45° FOV, 2212 x 1672 pixels, color fundus photograph: 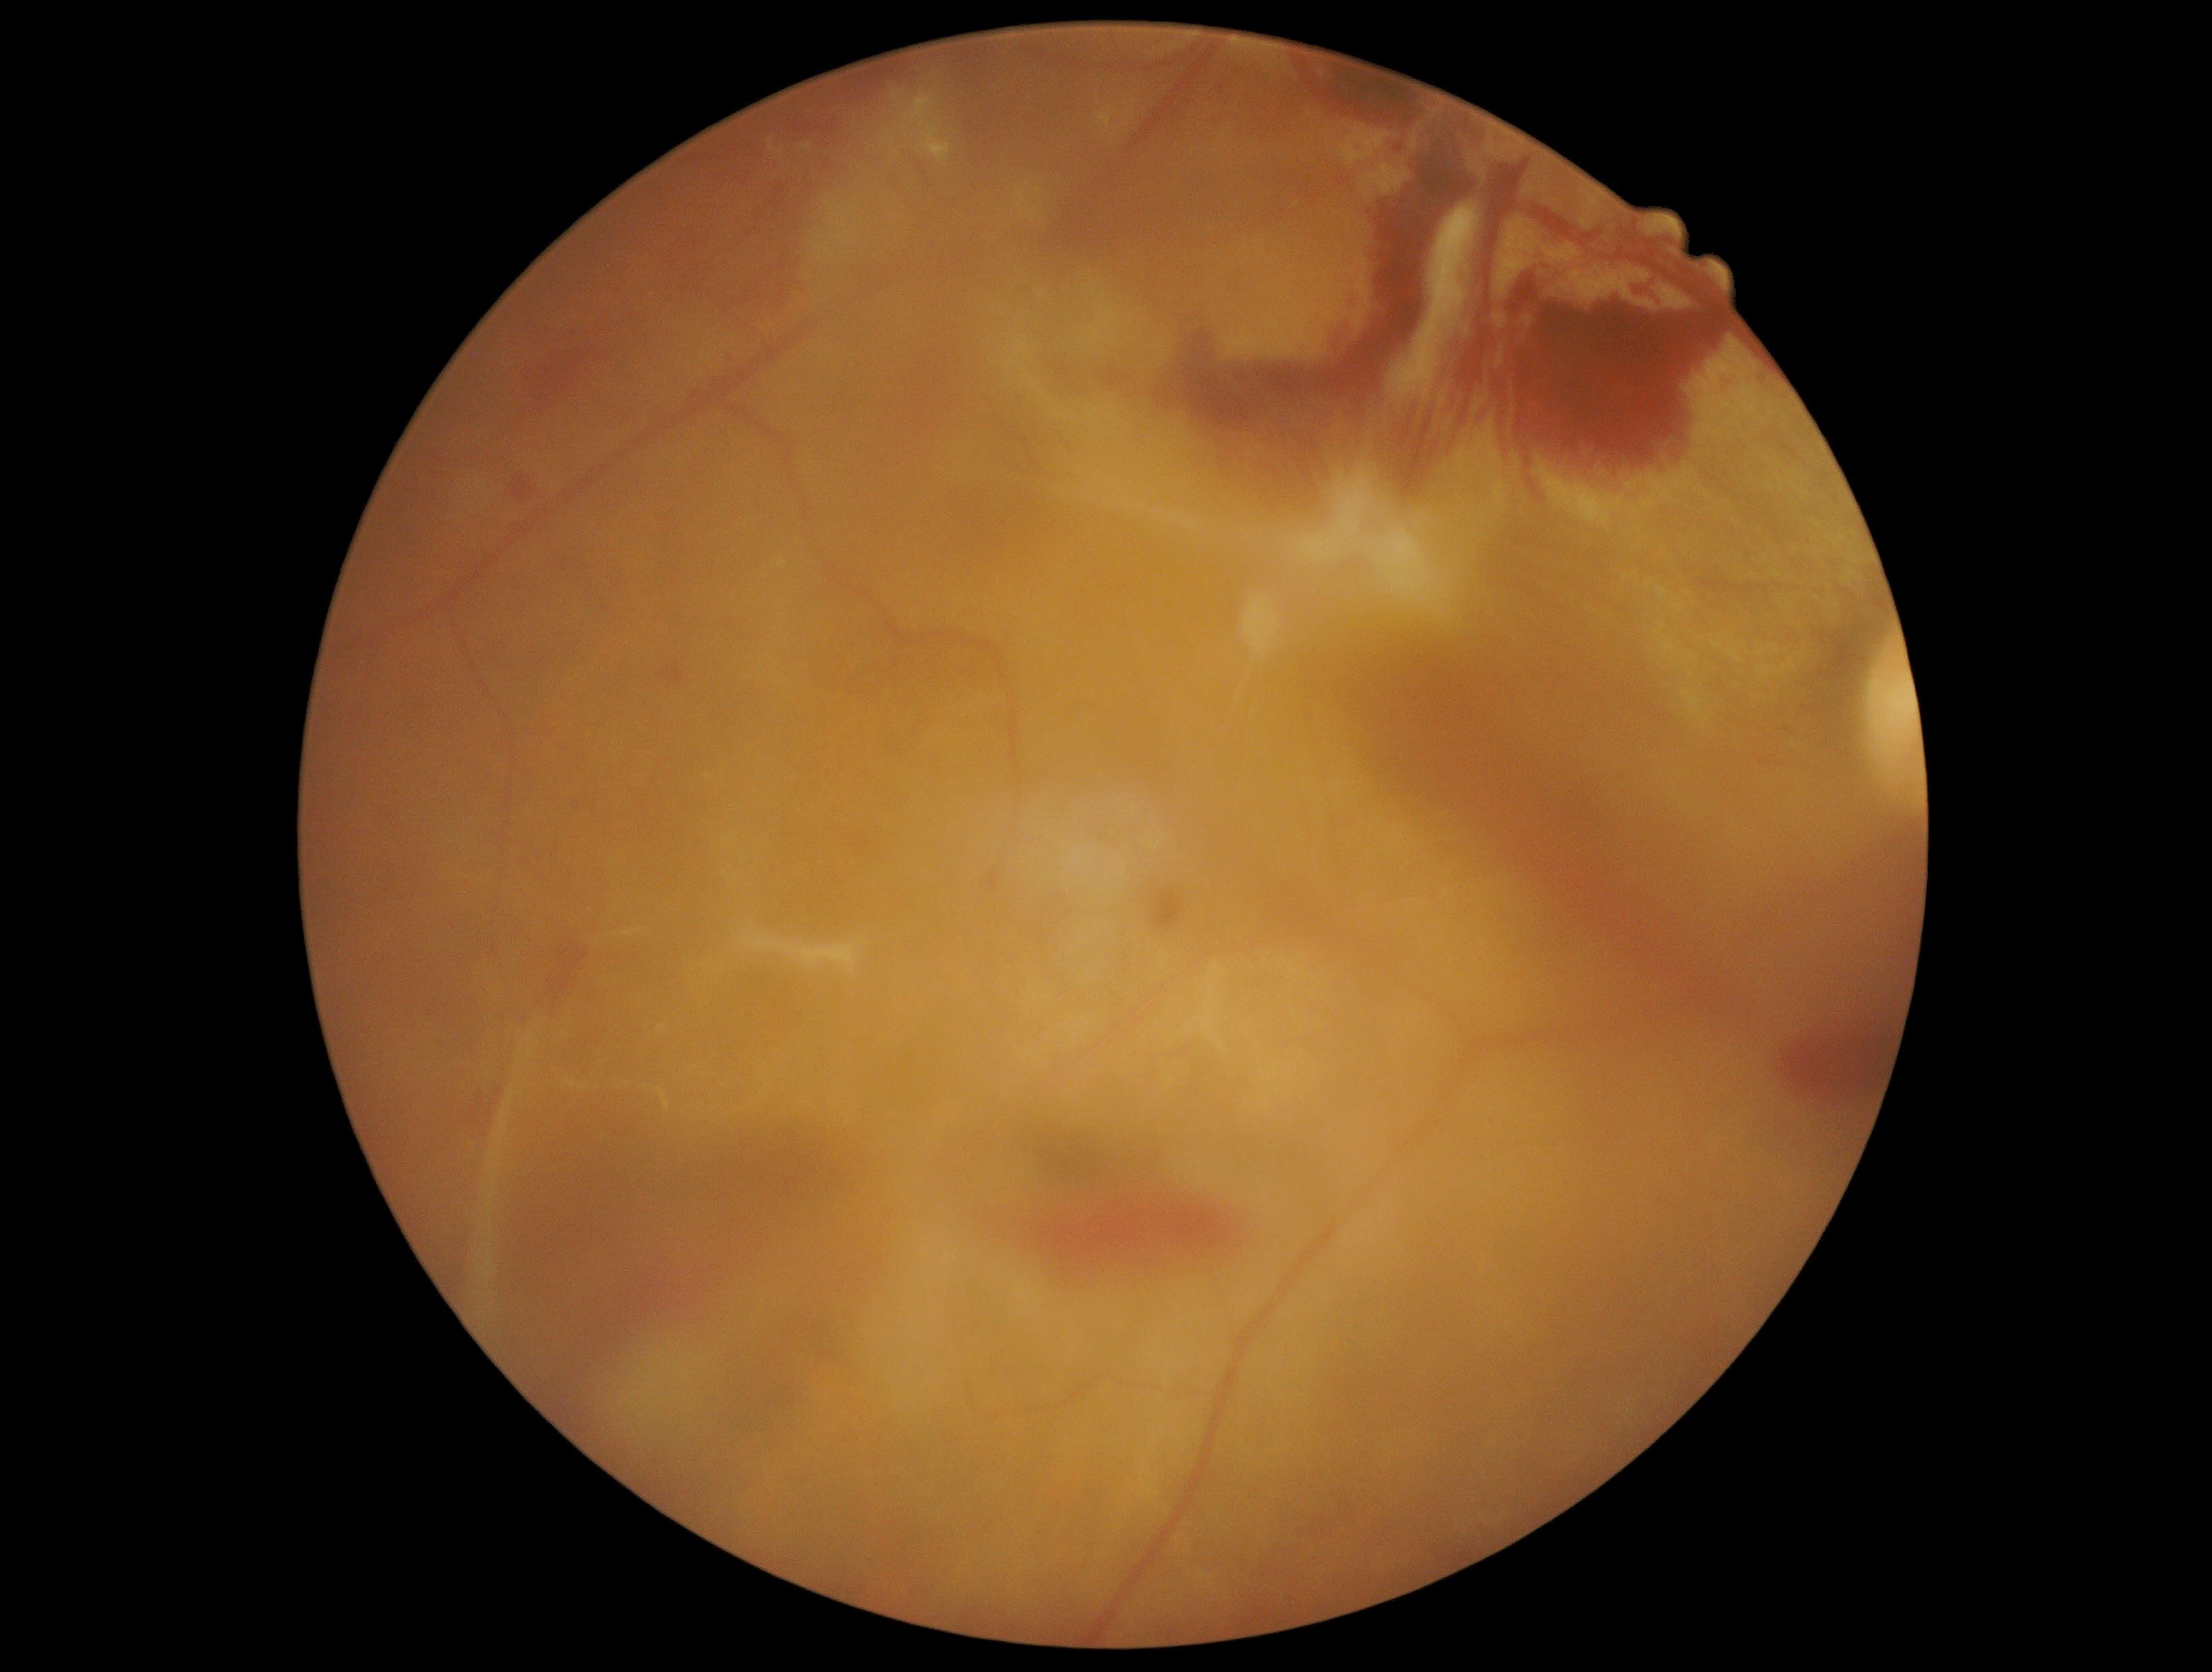 Diabetic retinopathy: 4/4.